Without pupil dilation · CFP · Davis DR grading · 45° field of view:
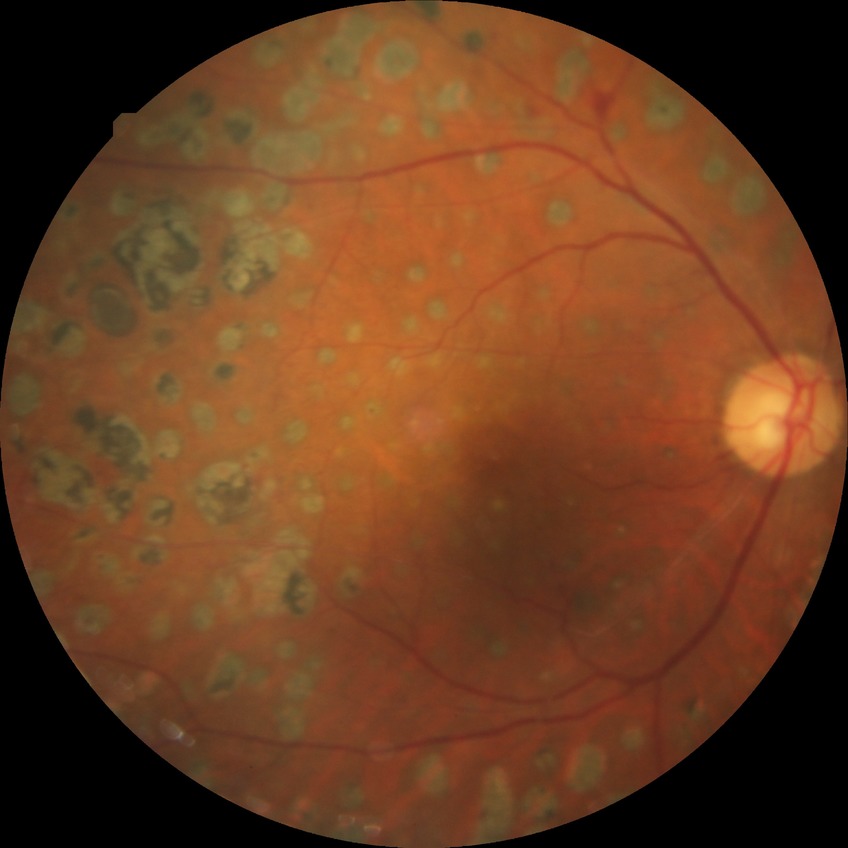 Diabetic retinopathy (DR) is PDR (proliferative diabetic retinopathy).